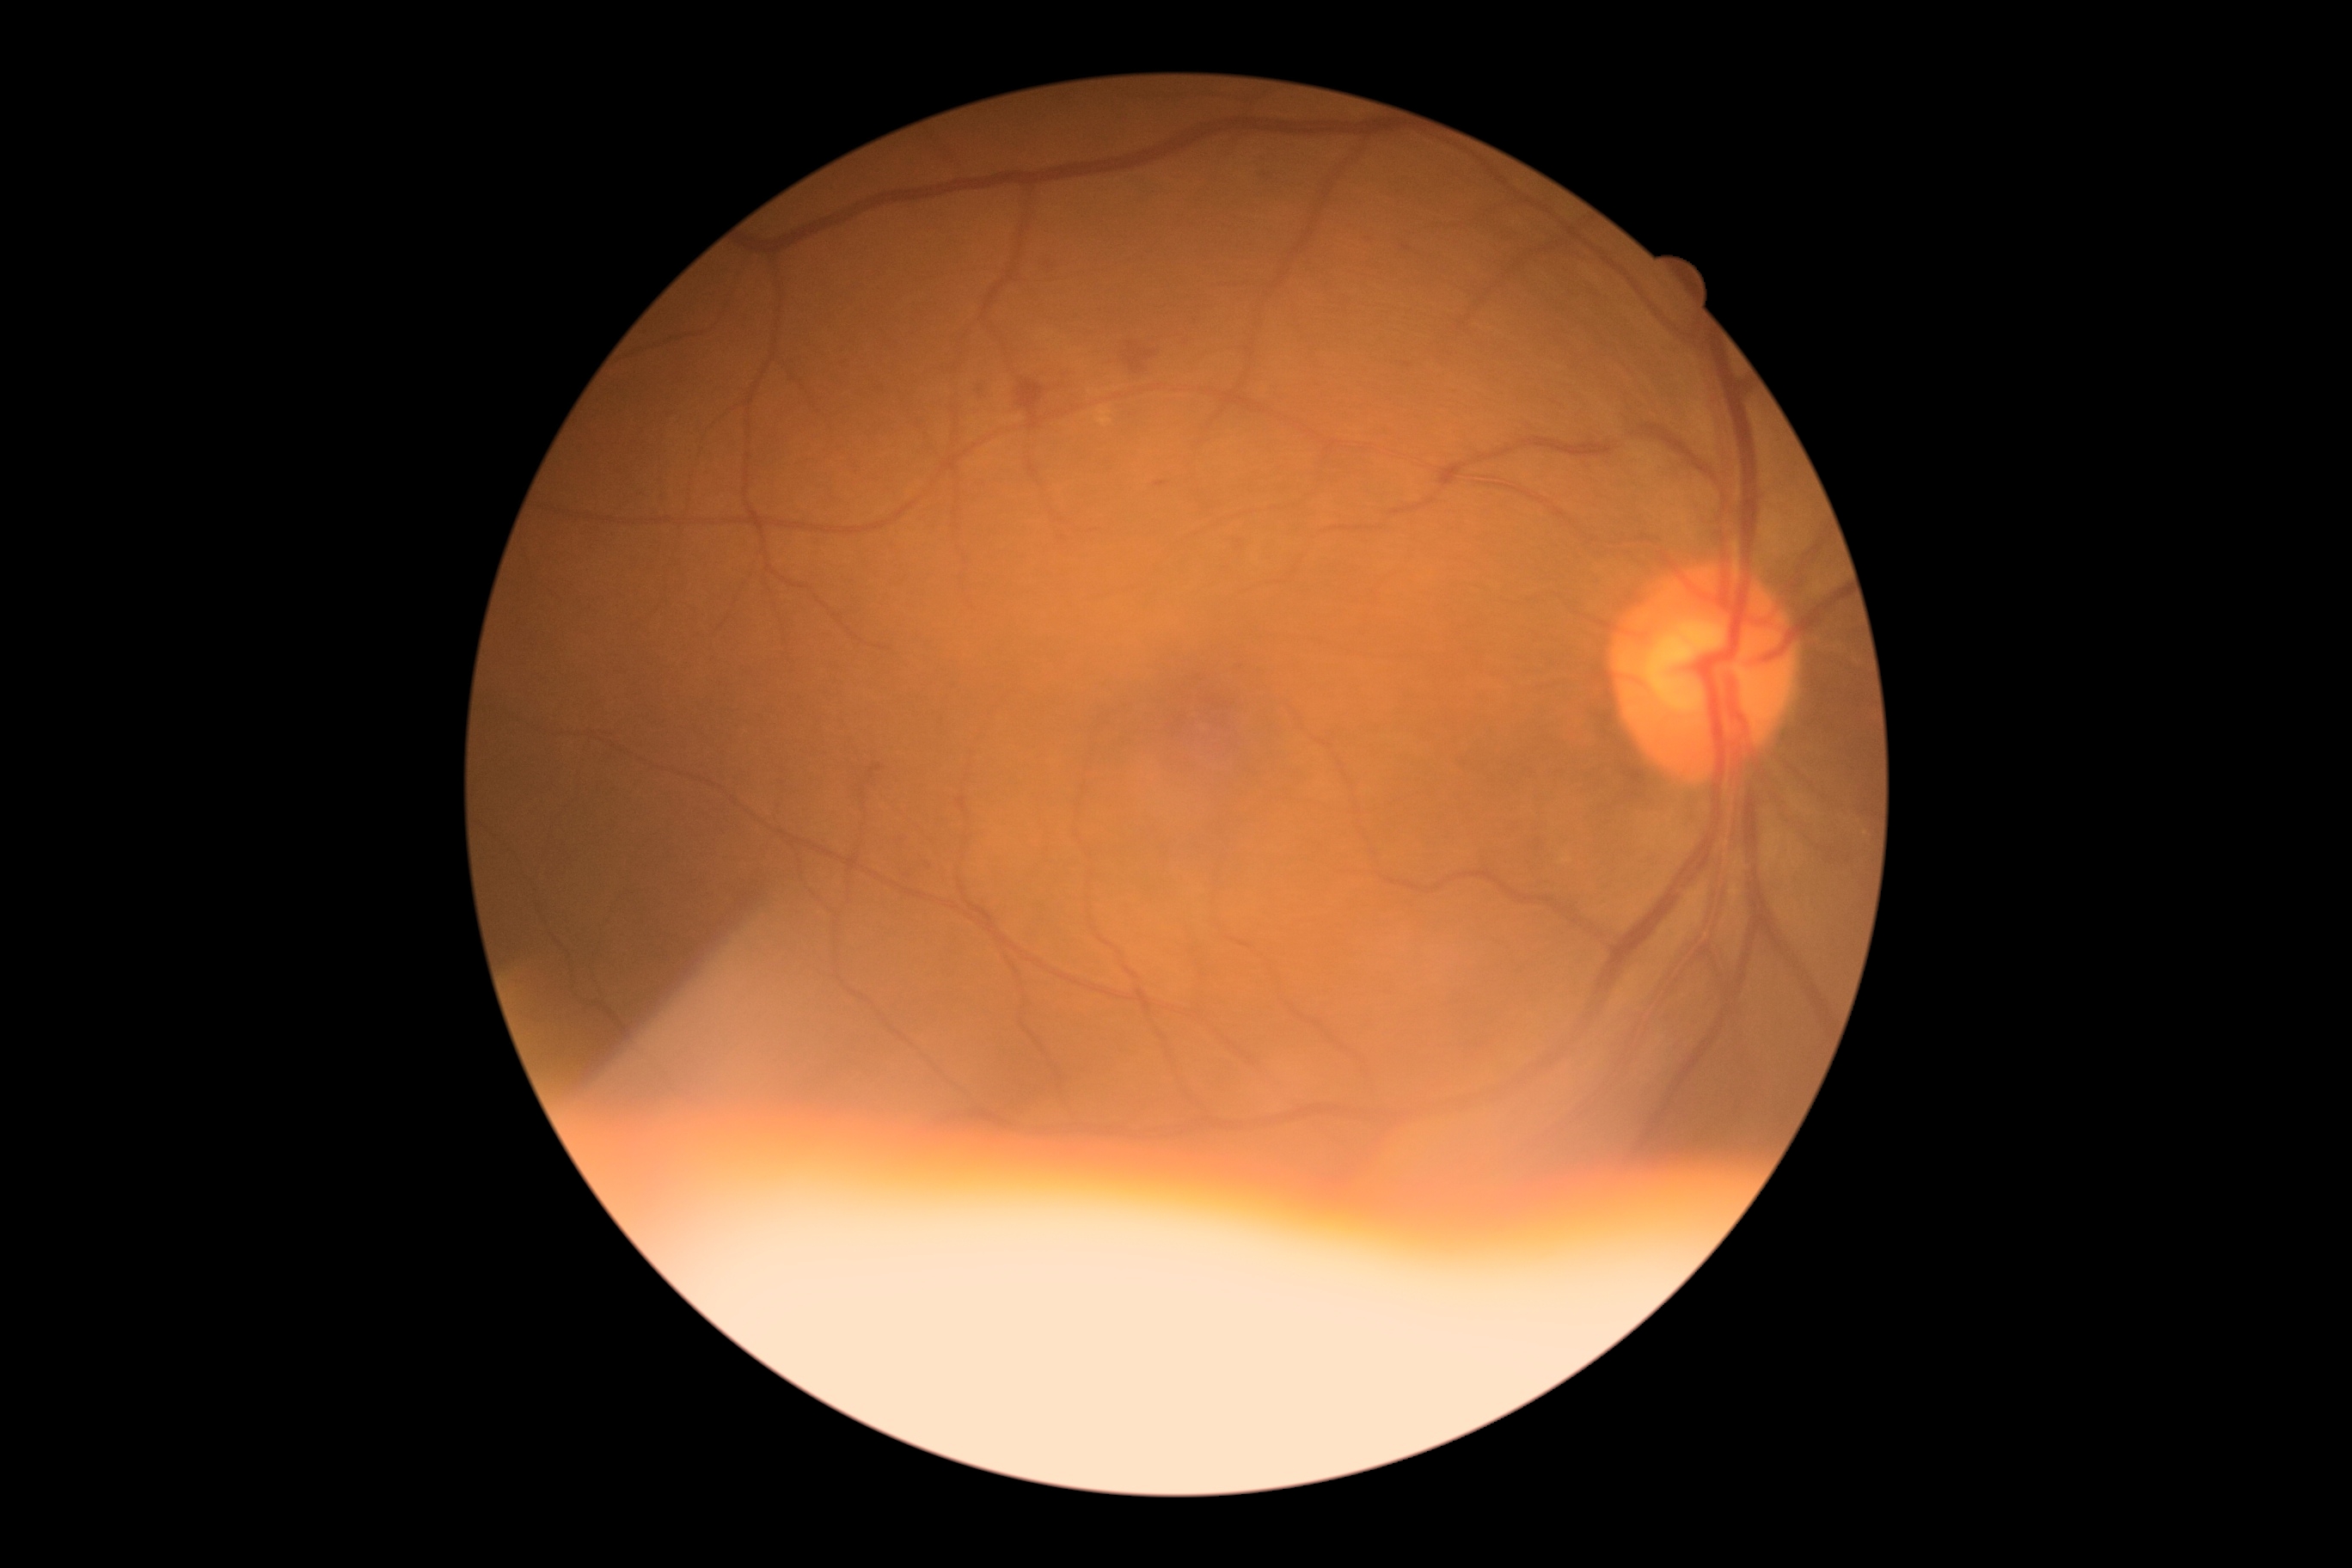
DR: grade 2 (moderate NPDR).
DR class: non-proliferative diabetic retinopathy.